CFP.
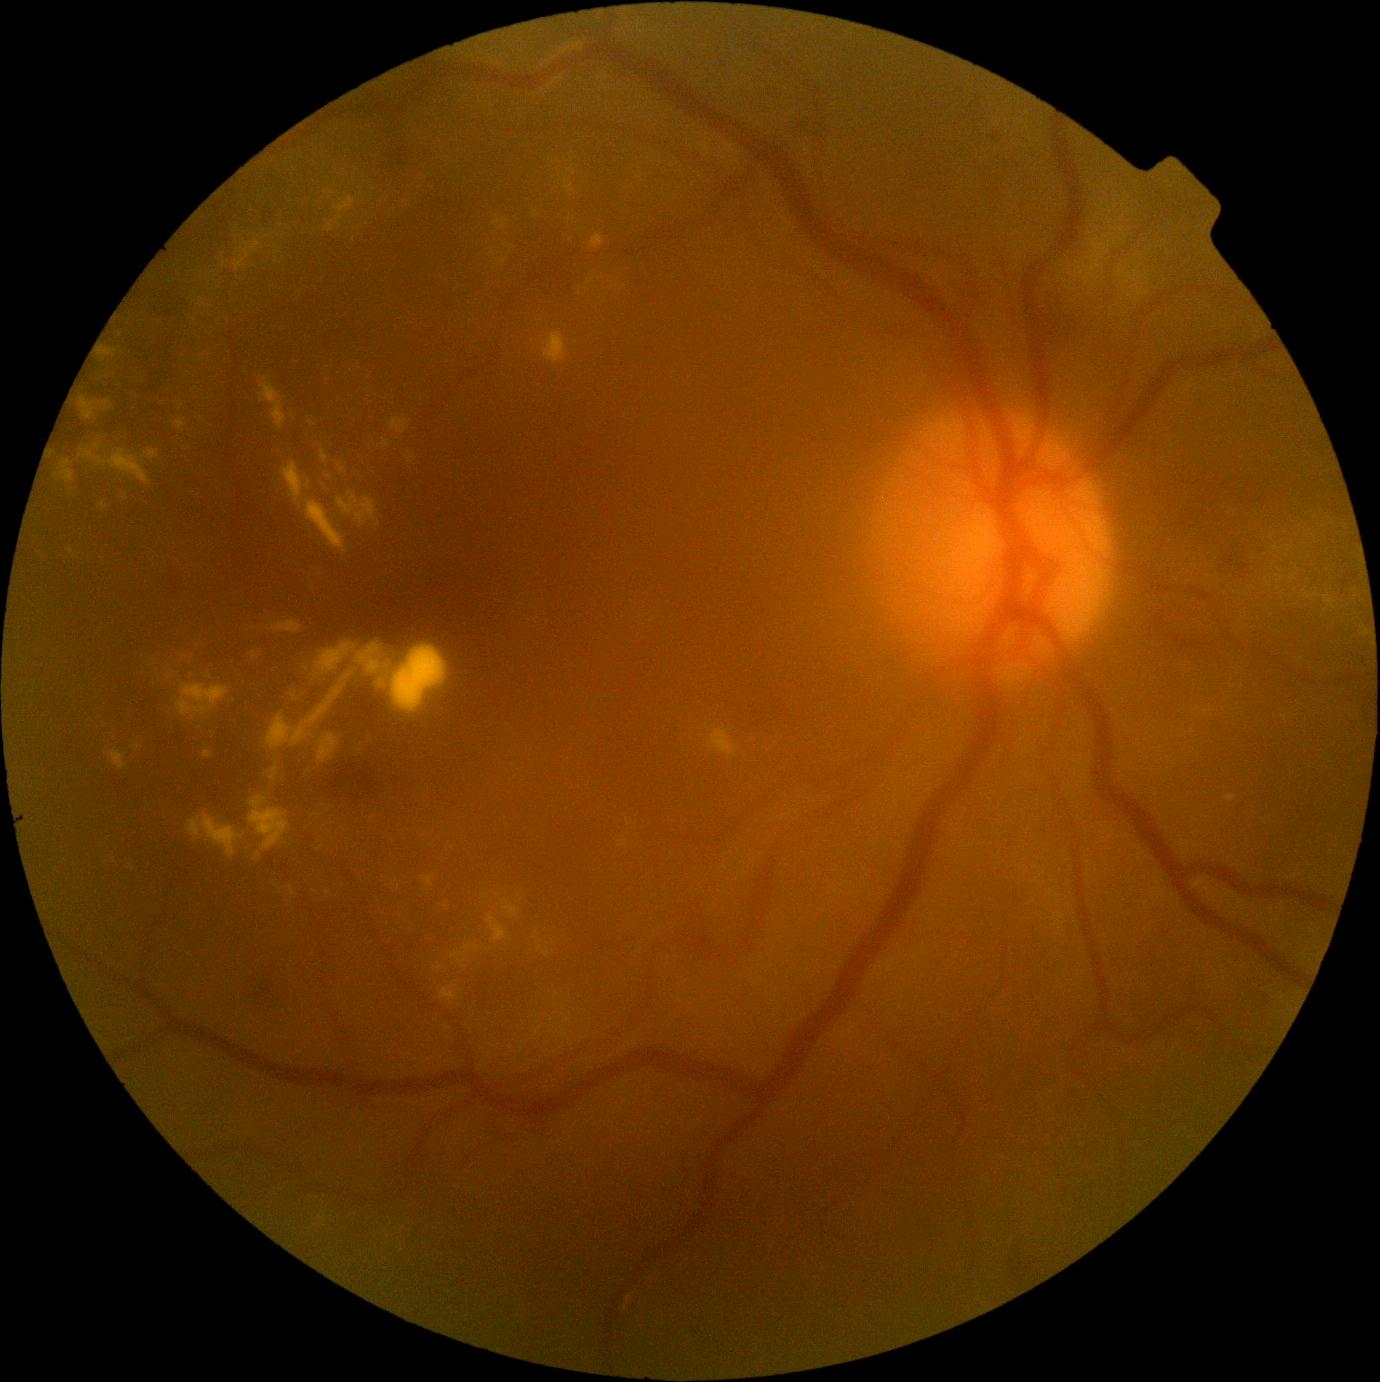 Diabetic retinopathy (DR) is grade 2 (moderate NPDR); non-proliferative diabetic retinopathy
Lesions identified (partial list):
hard exudates (EXs) (continued): <region>260, 383, 288, 430</region> | <region>1205, 710, 1213, 717</region> | <region>188, 814, 246, 858</region> | <region>145, 450, 159, 461</region> | <region>1225, 795, 1237, 802</region> | <region>440, 987, 459, 1001</region> | <region>493, 217, 509, 230</region> | <region>324, 190, 332, 194</region> | <region>339, 464, 346, 473</region> | <region>335, 197, 355, 216</region> | <region>1084, 274, 1096, 283</region> | <region>79, 398, 114, 421</region>
Additional small EXs near [807, 971] | [1137, 274] | [201, 361] | [1198, 709] | [328, 381] | [265, 380]